Posterior pole color fundus photograph · 45 degree fundus photograph:
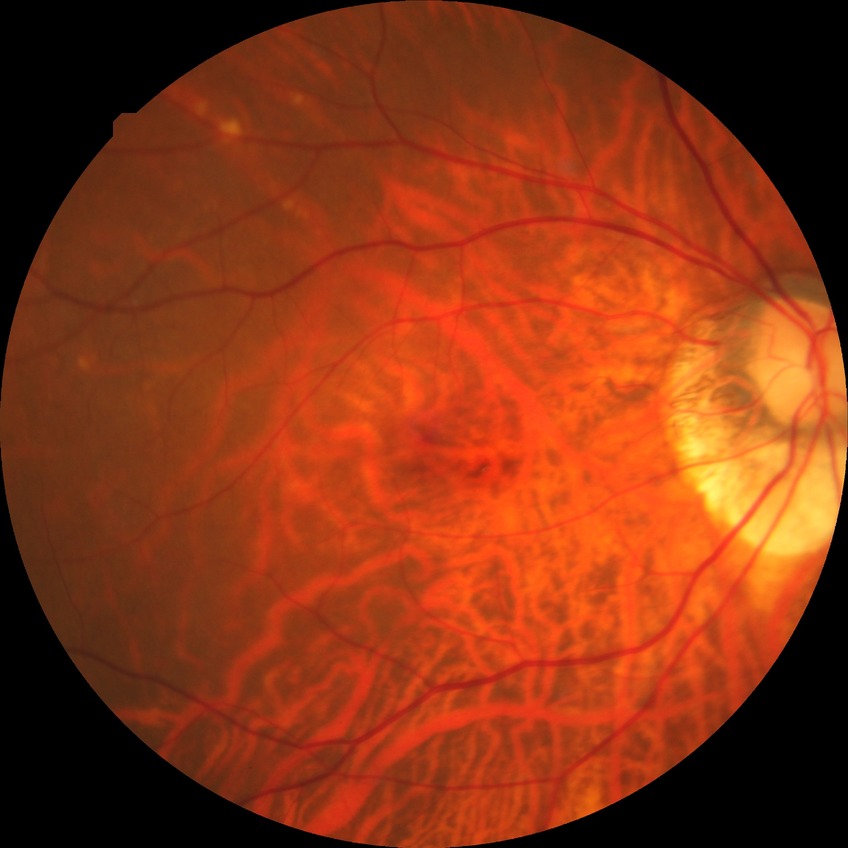

diabetic retinopathy stage = no diabetic retinopathy.